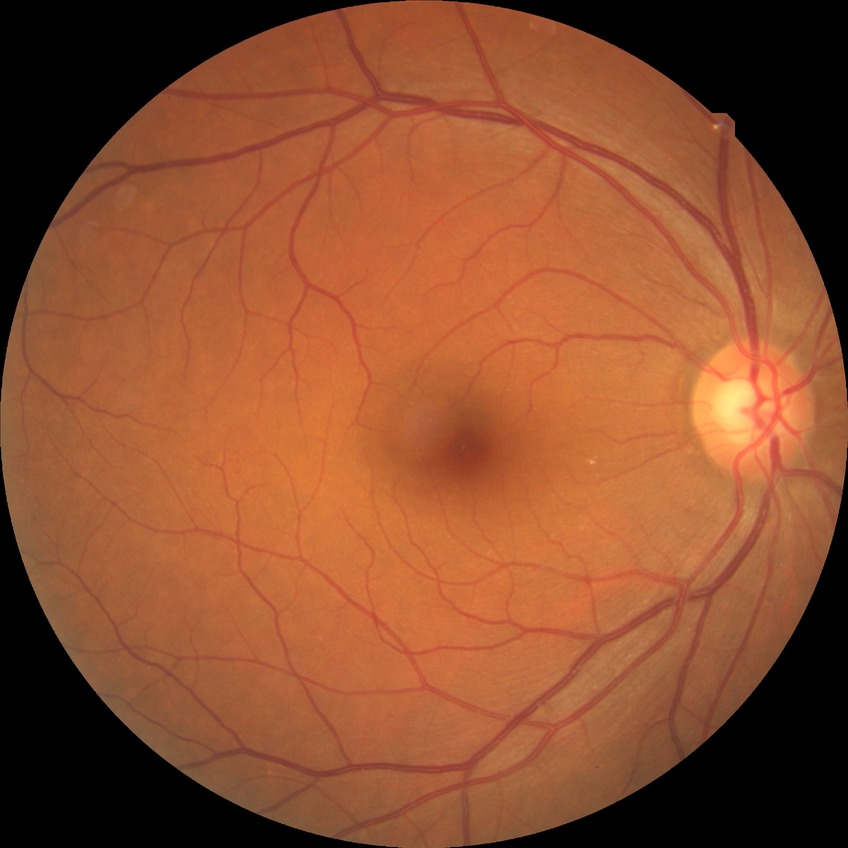

Diabetic retinopathy (DR) is NDR (no diabetic retinopathy).